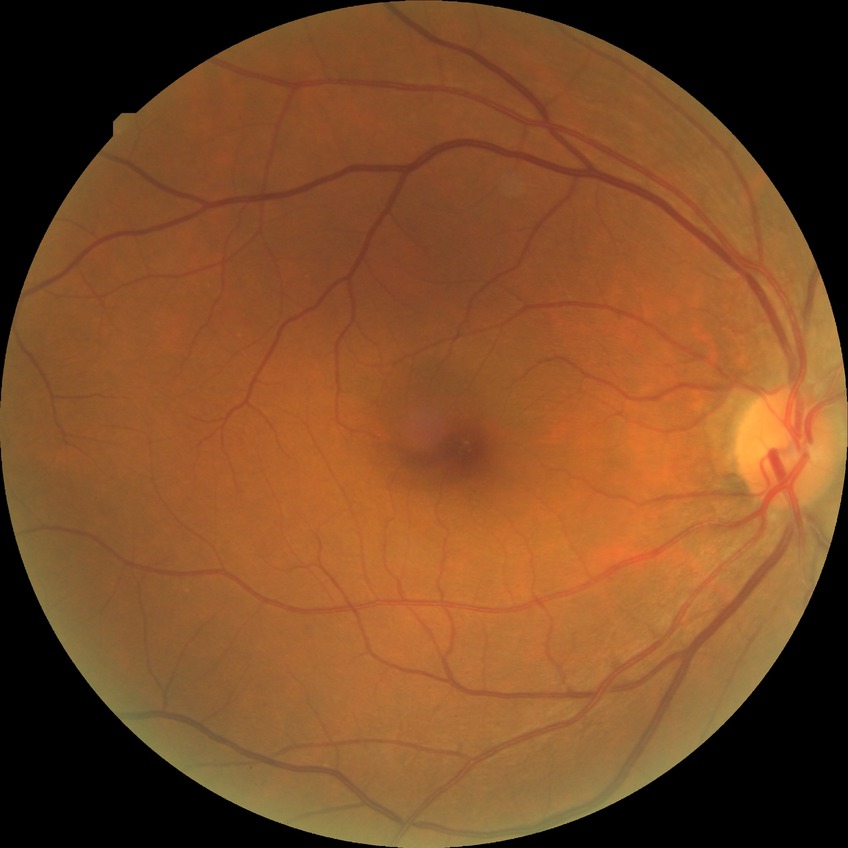
diabetic retinopathy (DR)=no diabetic retinopathy (NDR).